45° FOV; 2212 by 1659 pixels; retinal fundus photograph.
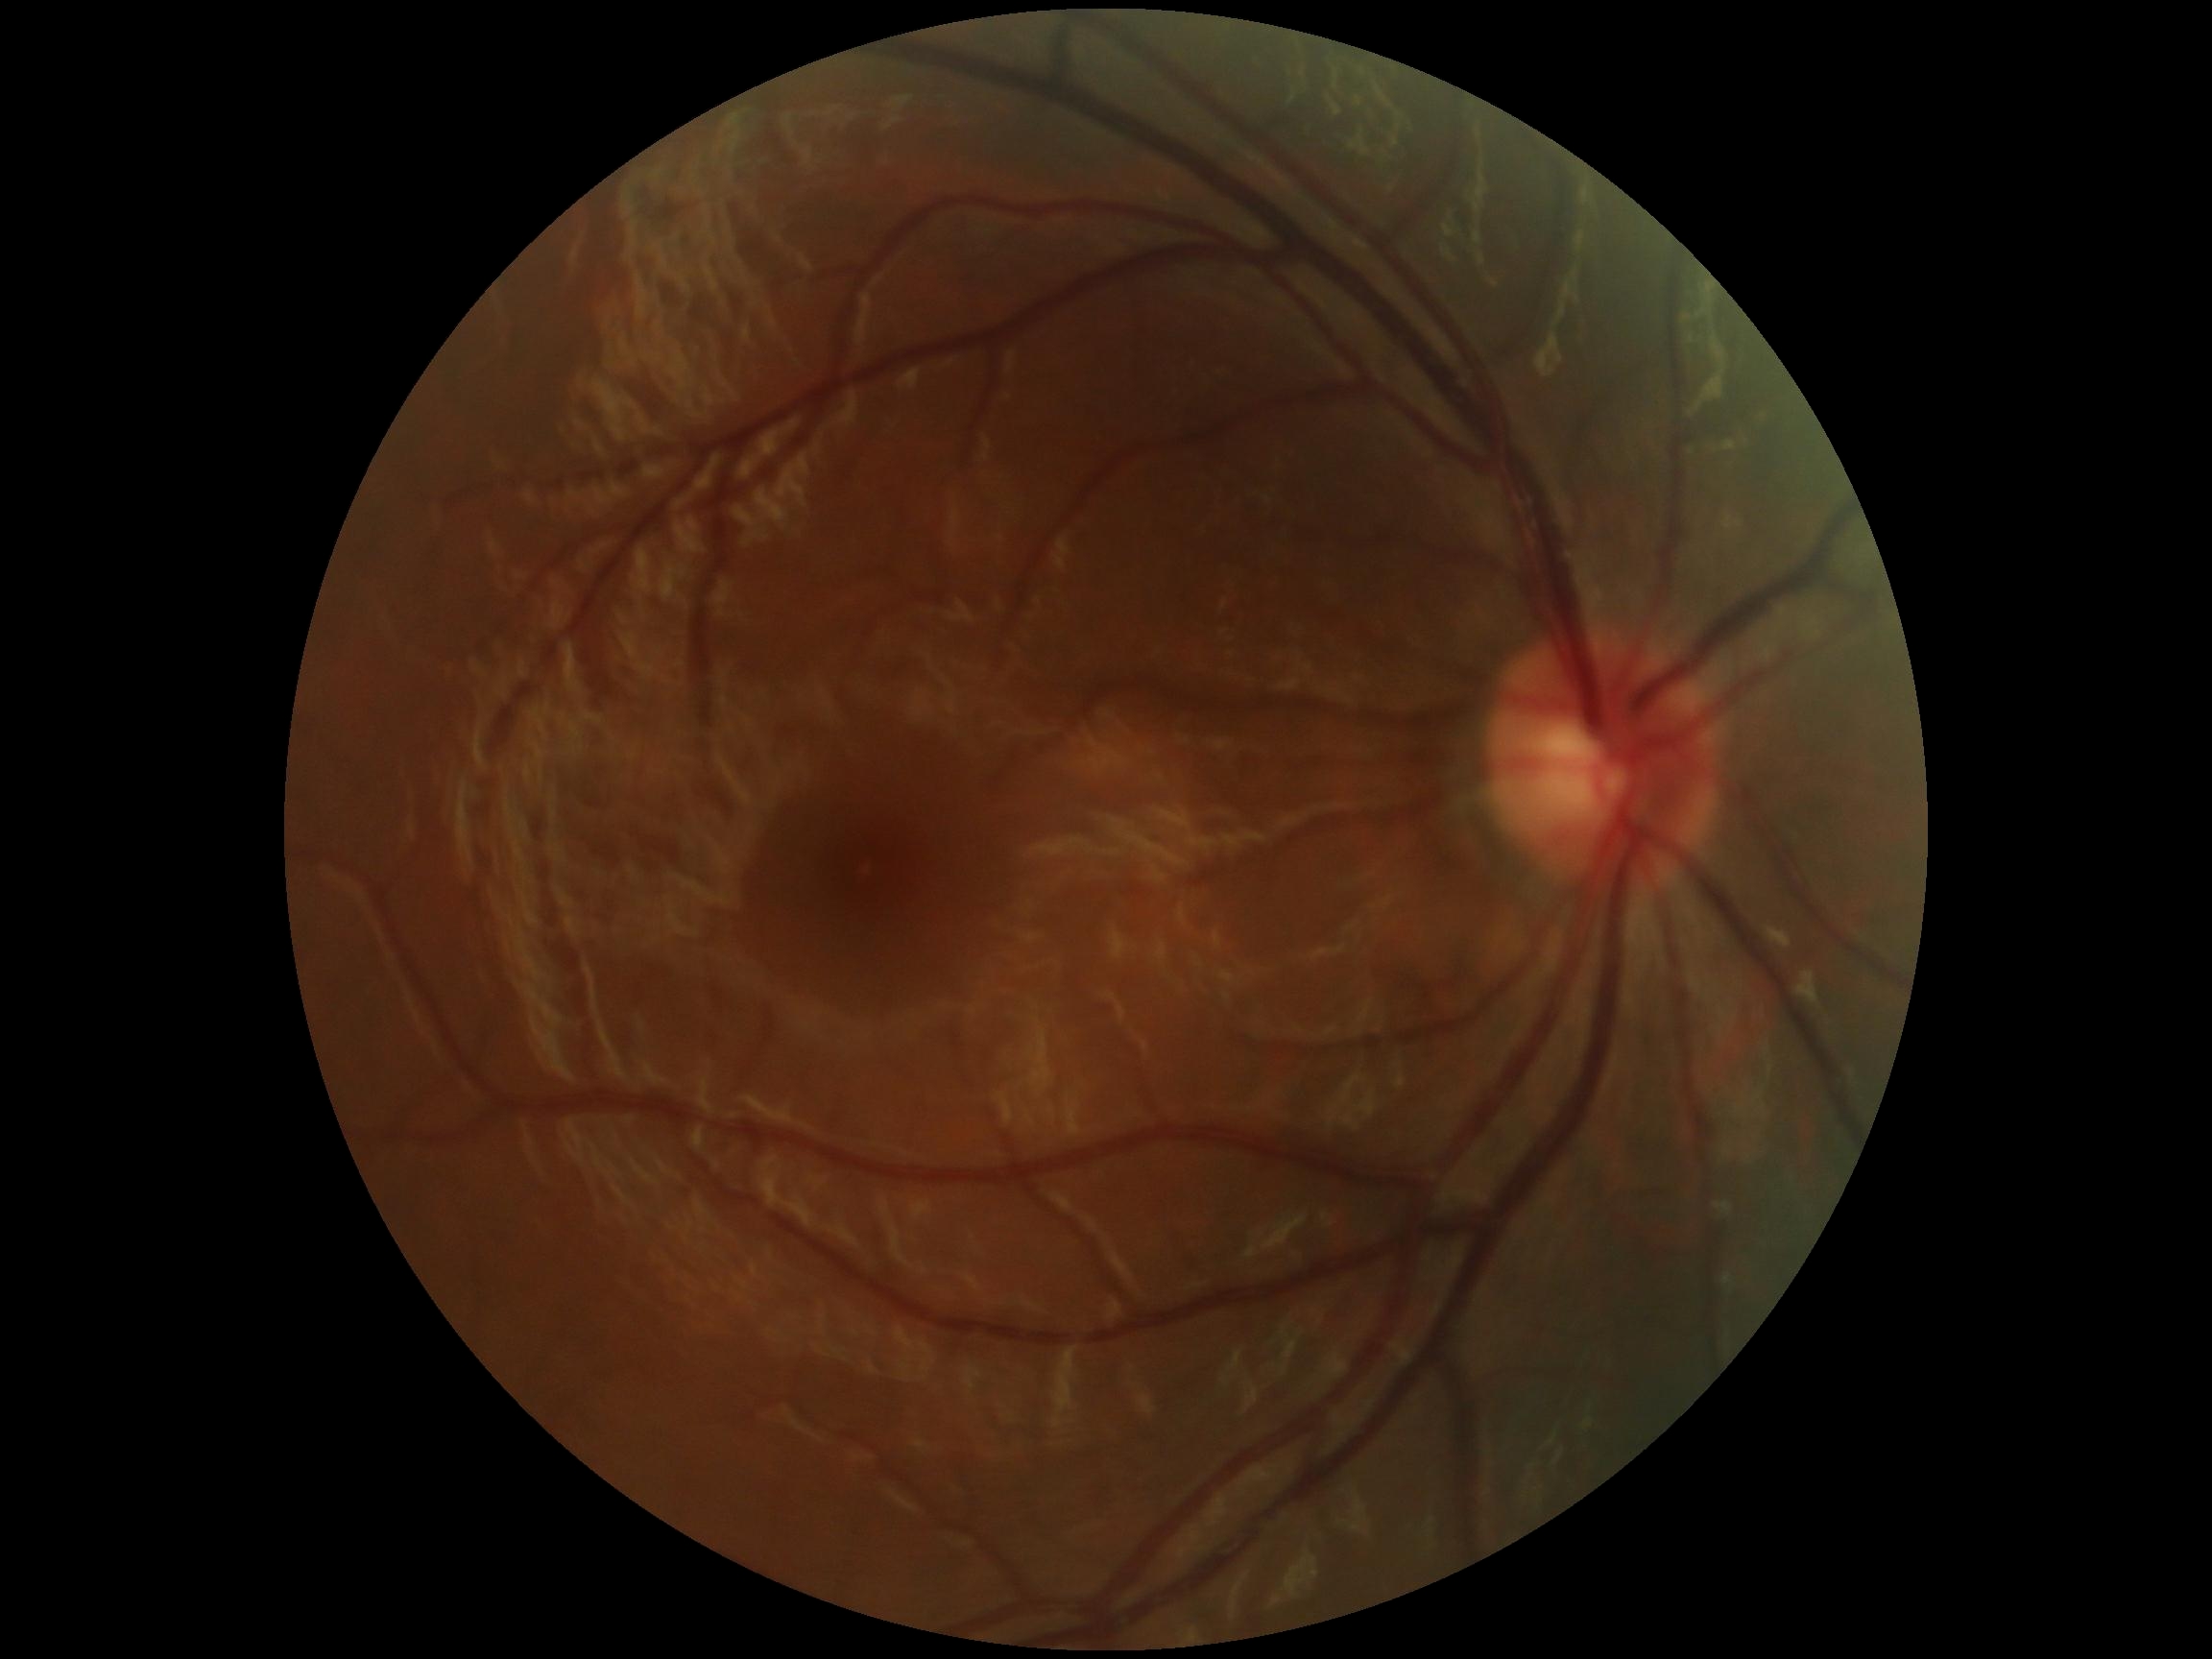 Diabetic retinopathy (DR) is grade 0.